Acquired with a NIDEK AFC-230 — 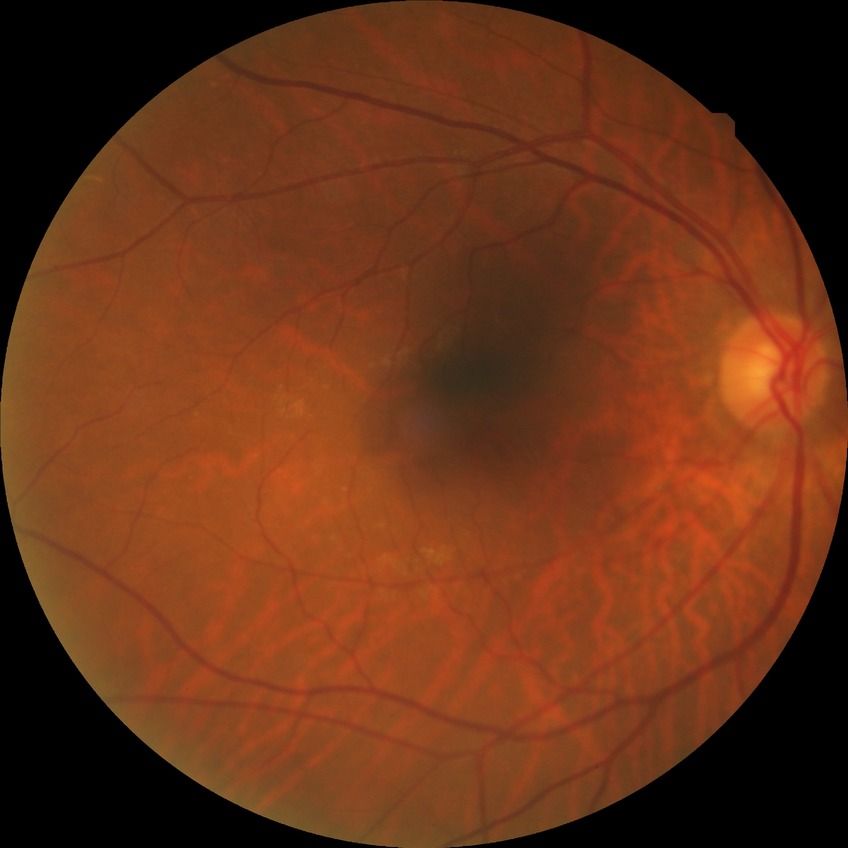
diabetic retinopathy (DR)=no diabetic retinopathy (NDR).